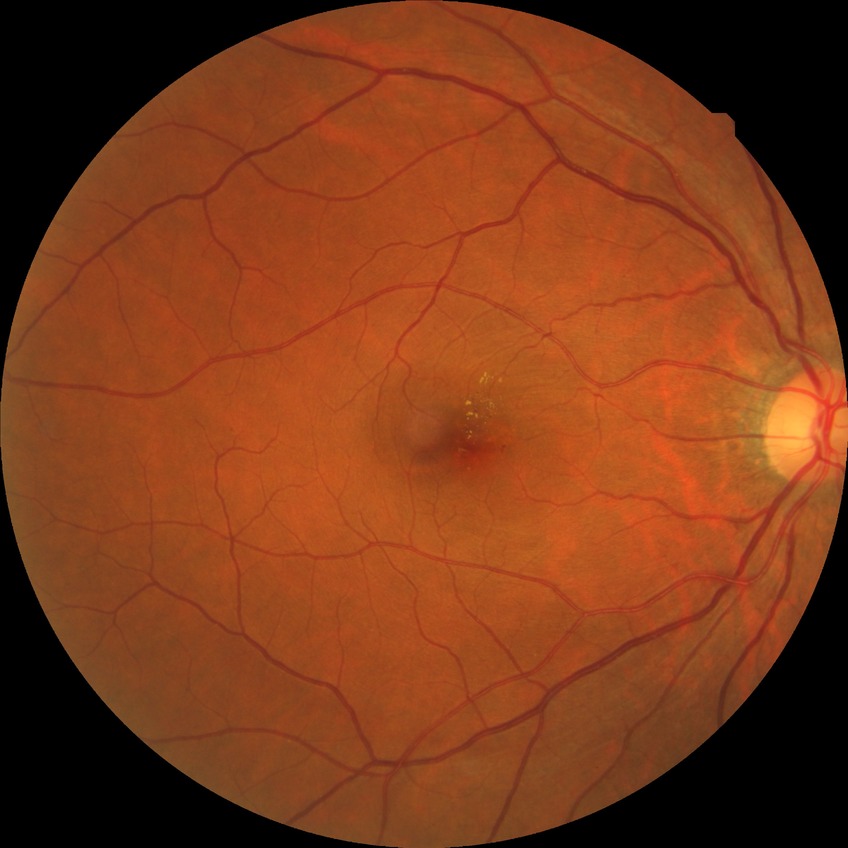
Findings:
– diabetic retinopathy (DR): SDR (simple diabetic retinopathy)
– DR class: non-proliferative diabetic retinopathy